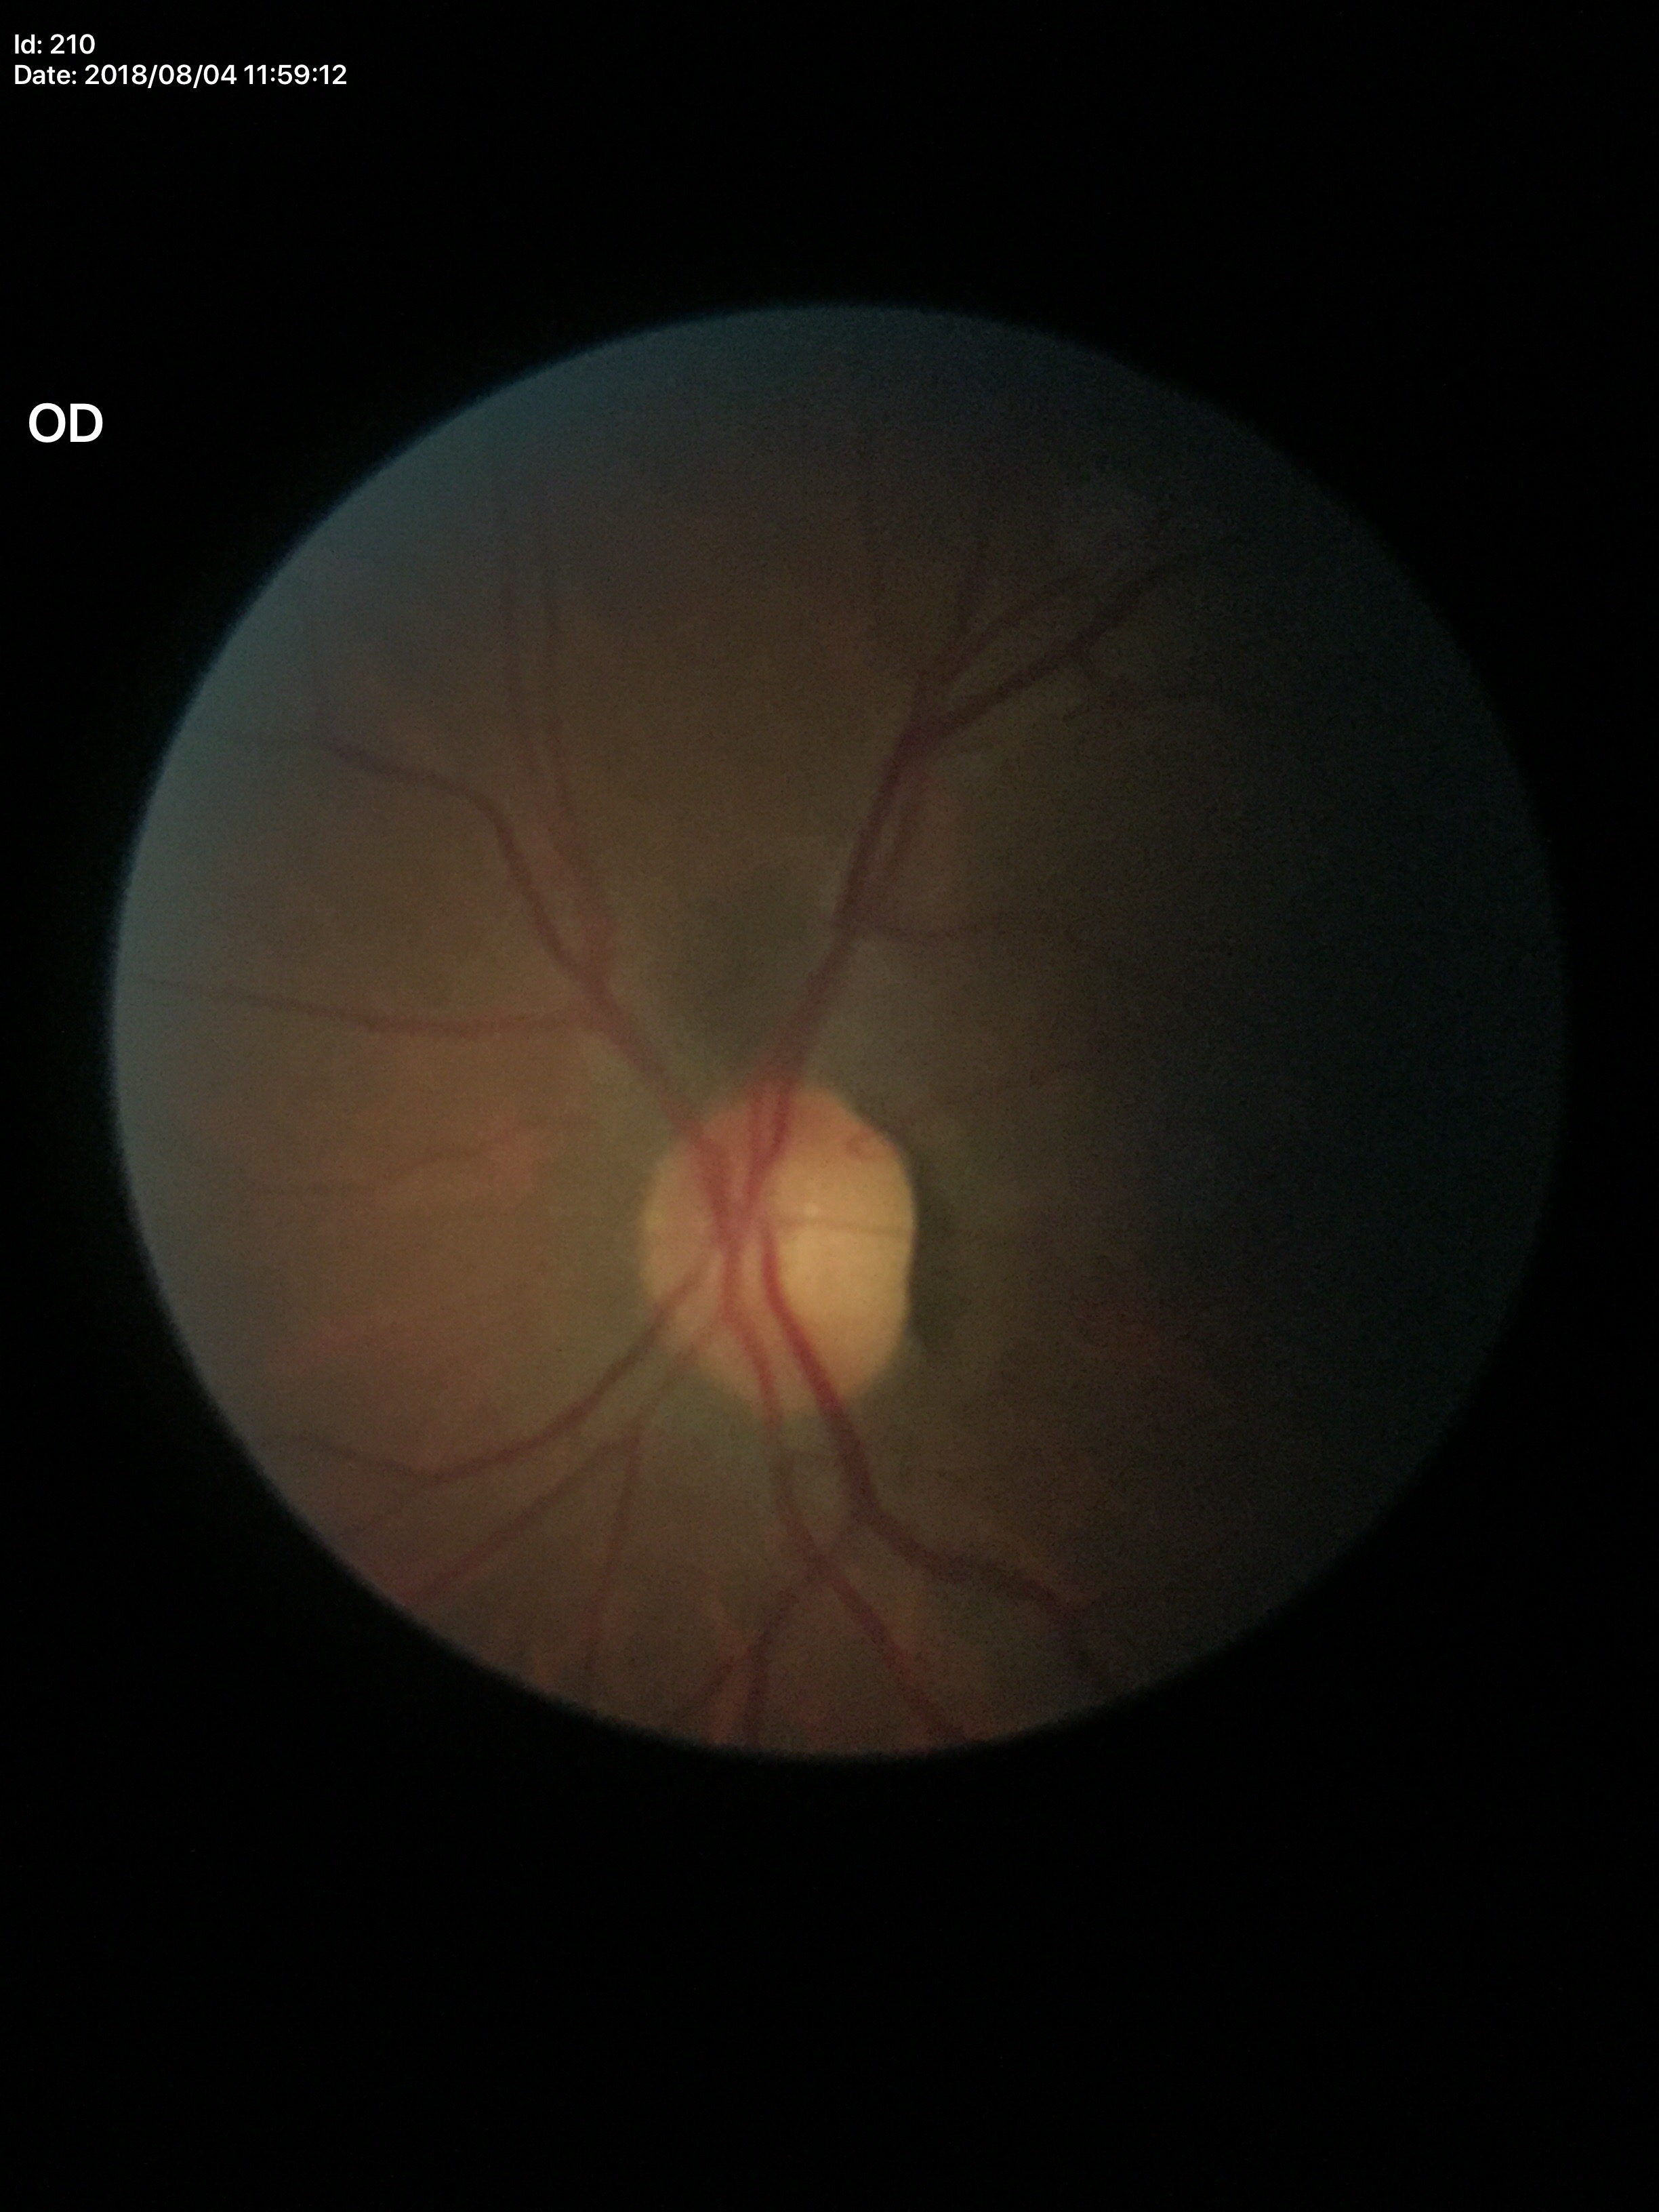
horizontal cup-to-disc ratio = 0.60; Glaucoma screening impression = negative; vertical CDR = 0.57.